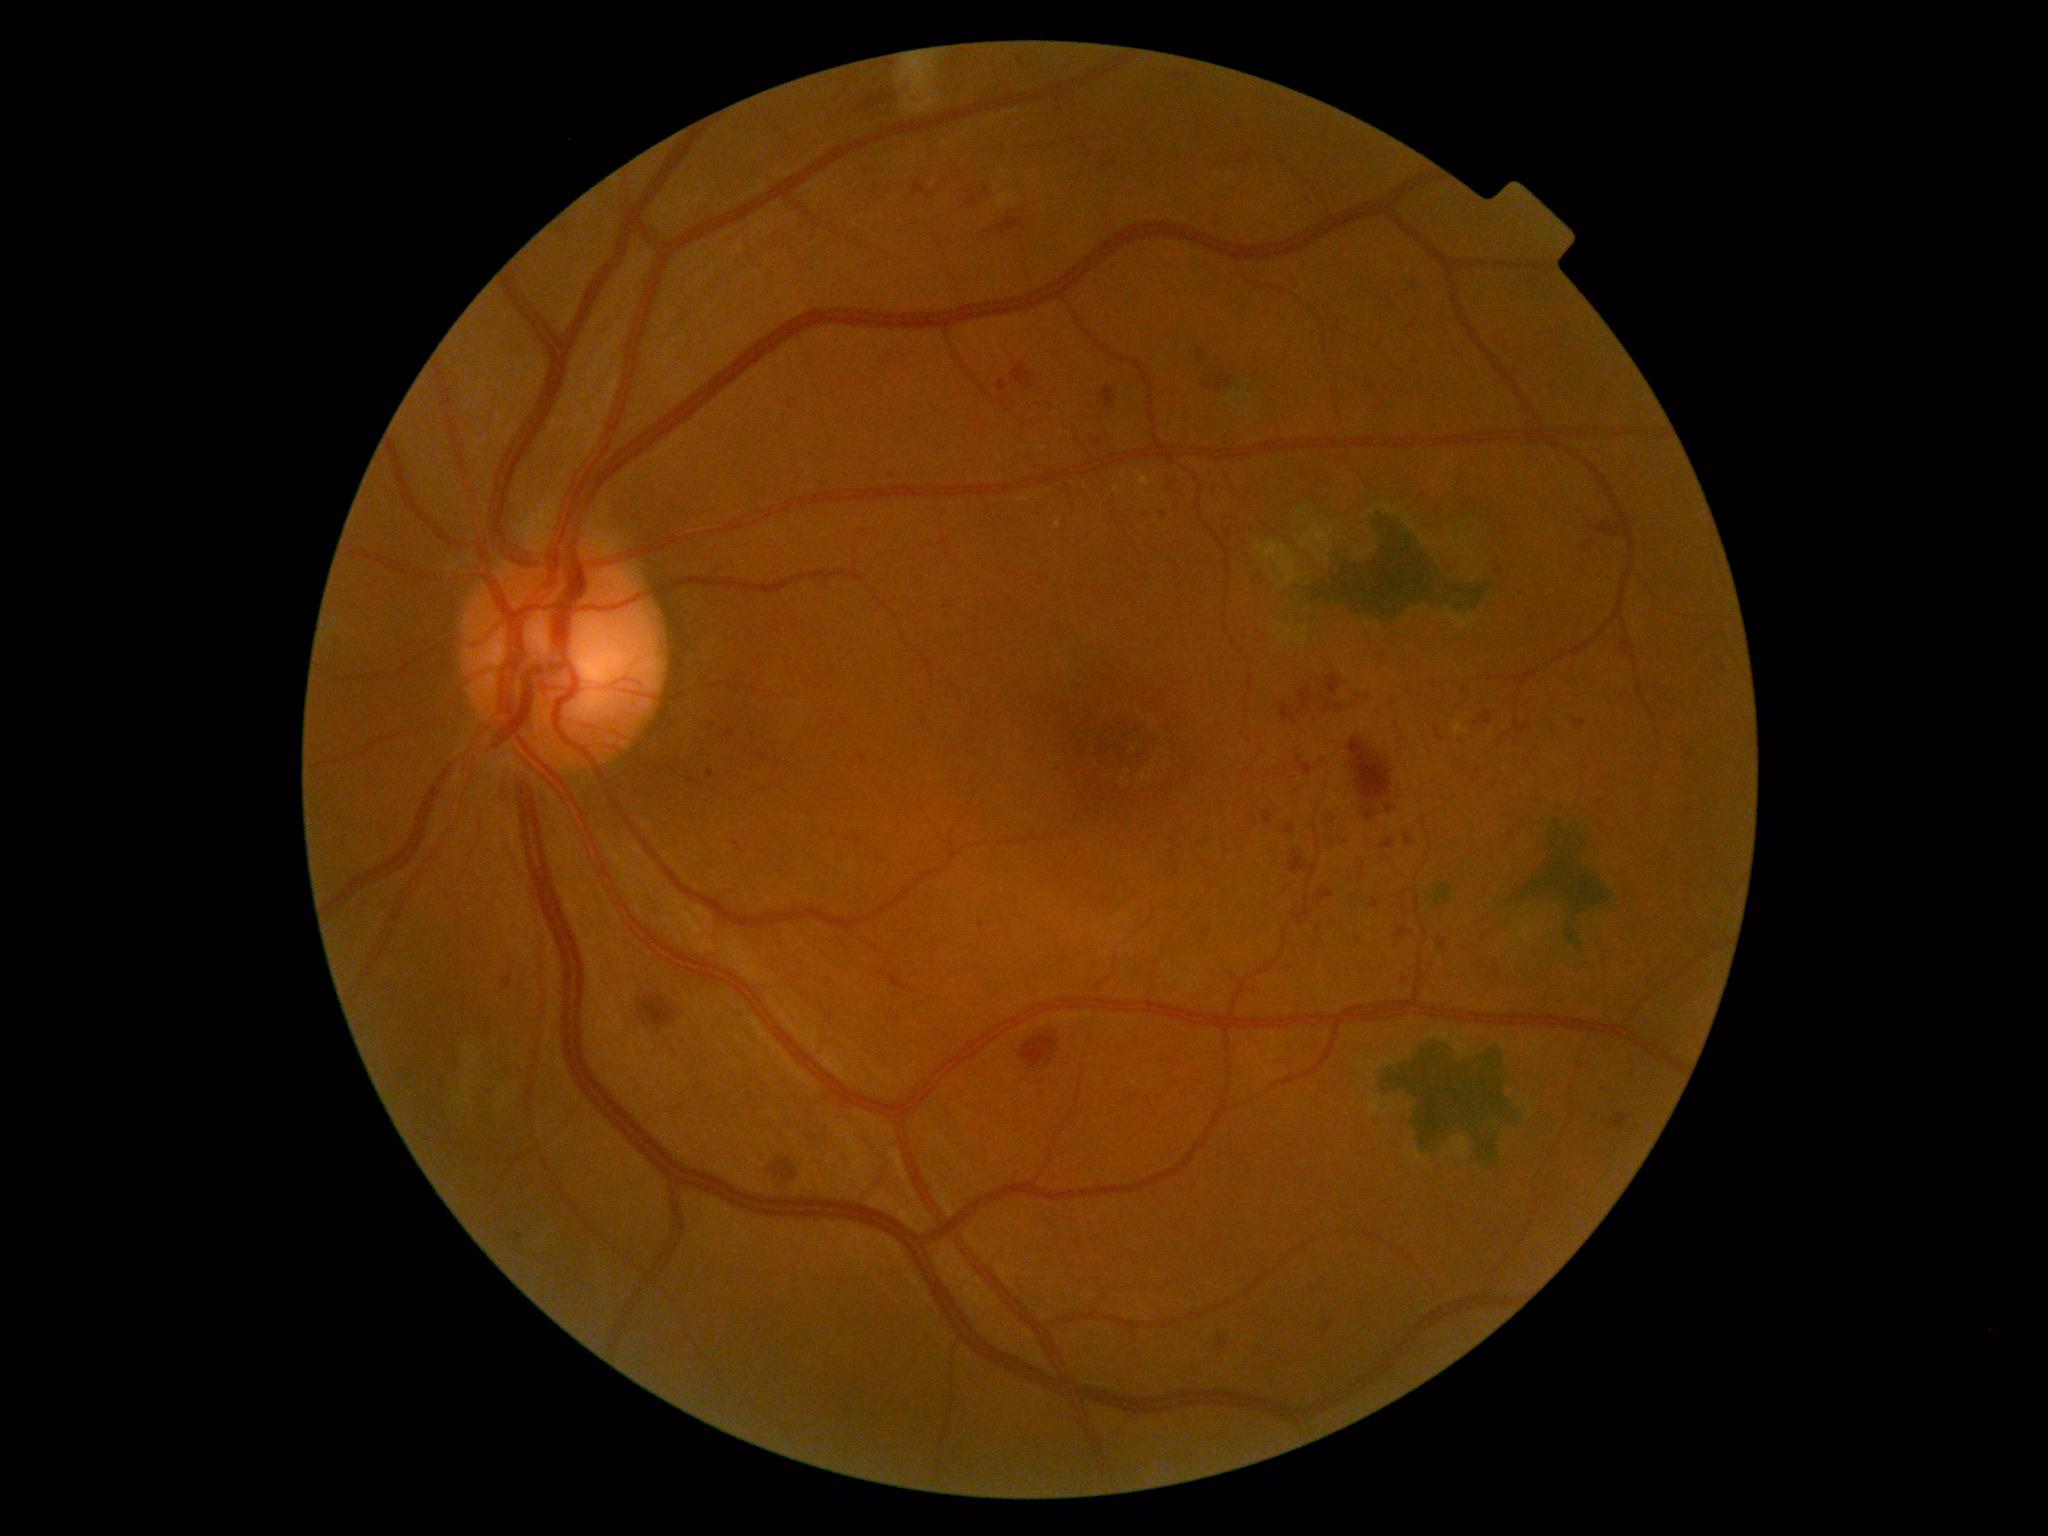

diabetic retinopathy grade=moderate NPDR (2).